2048 x 1536 pixels · fundus photo: 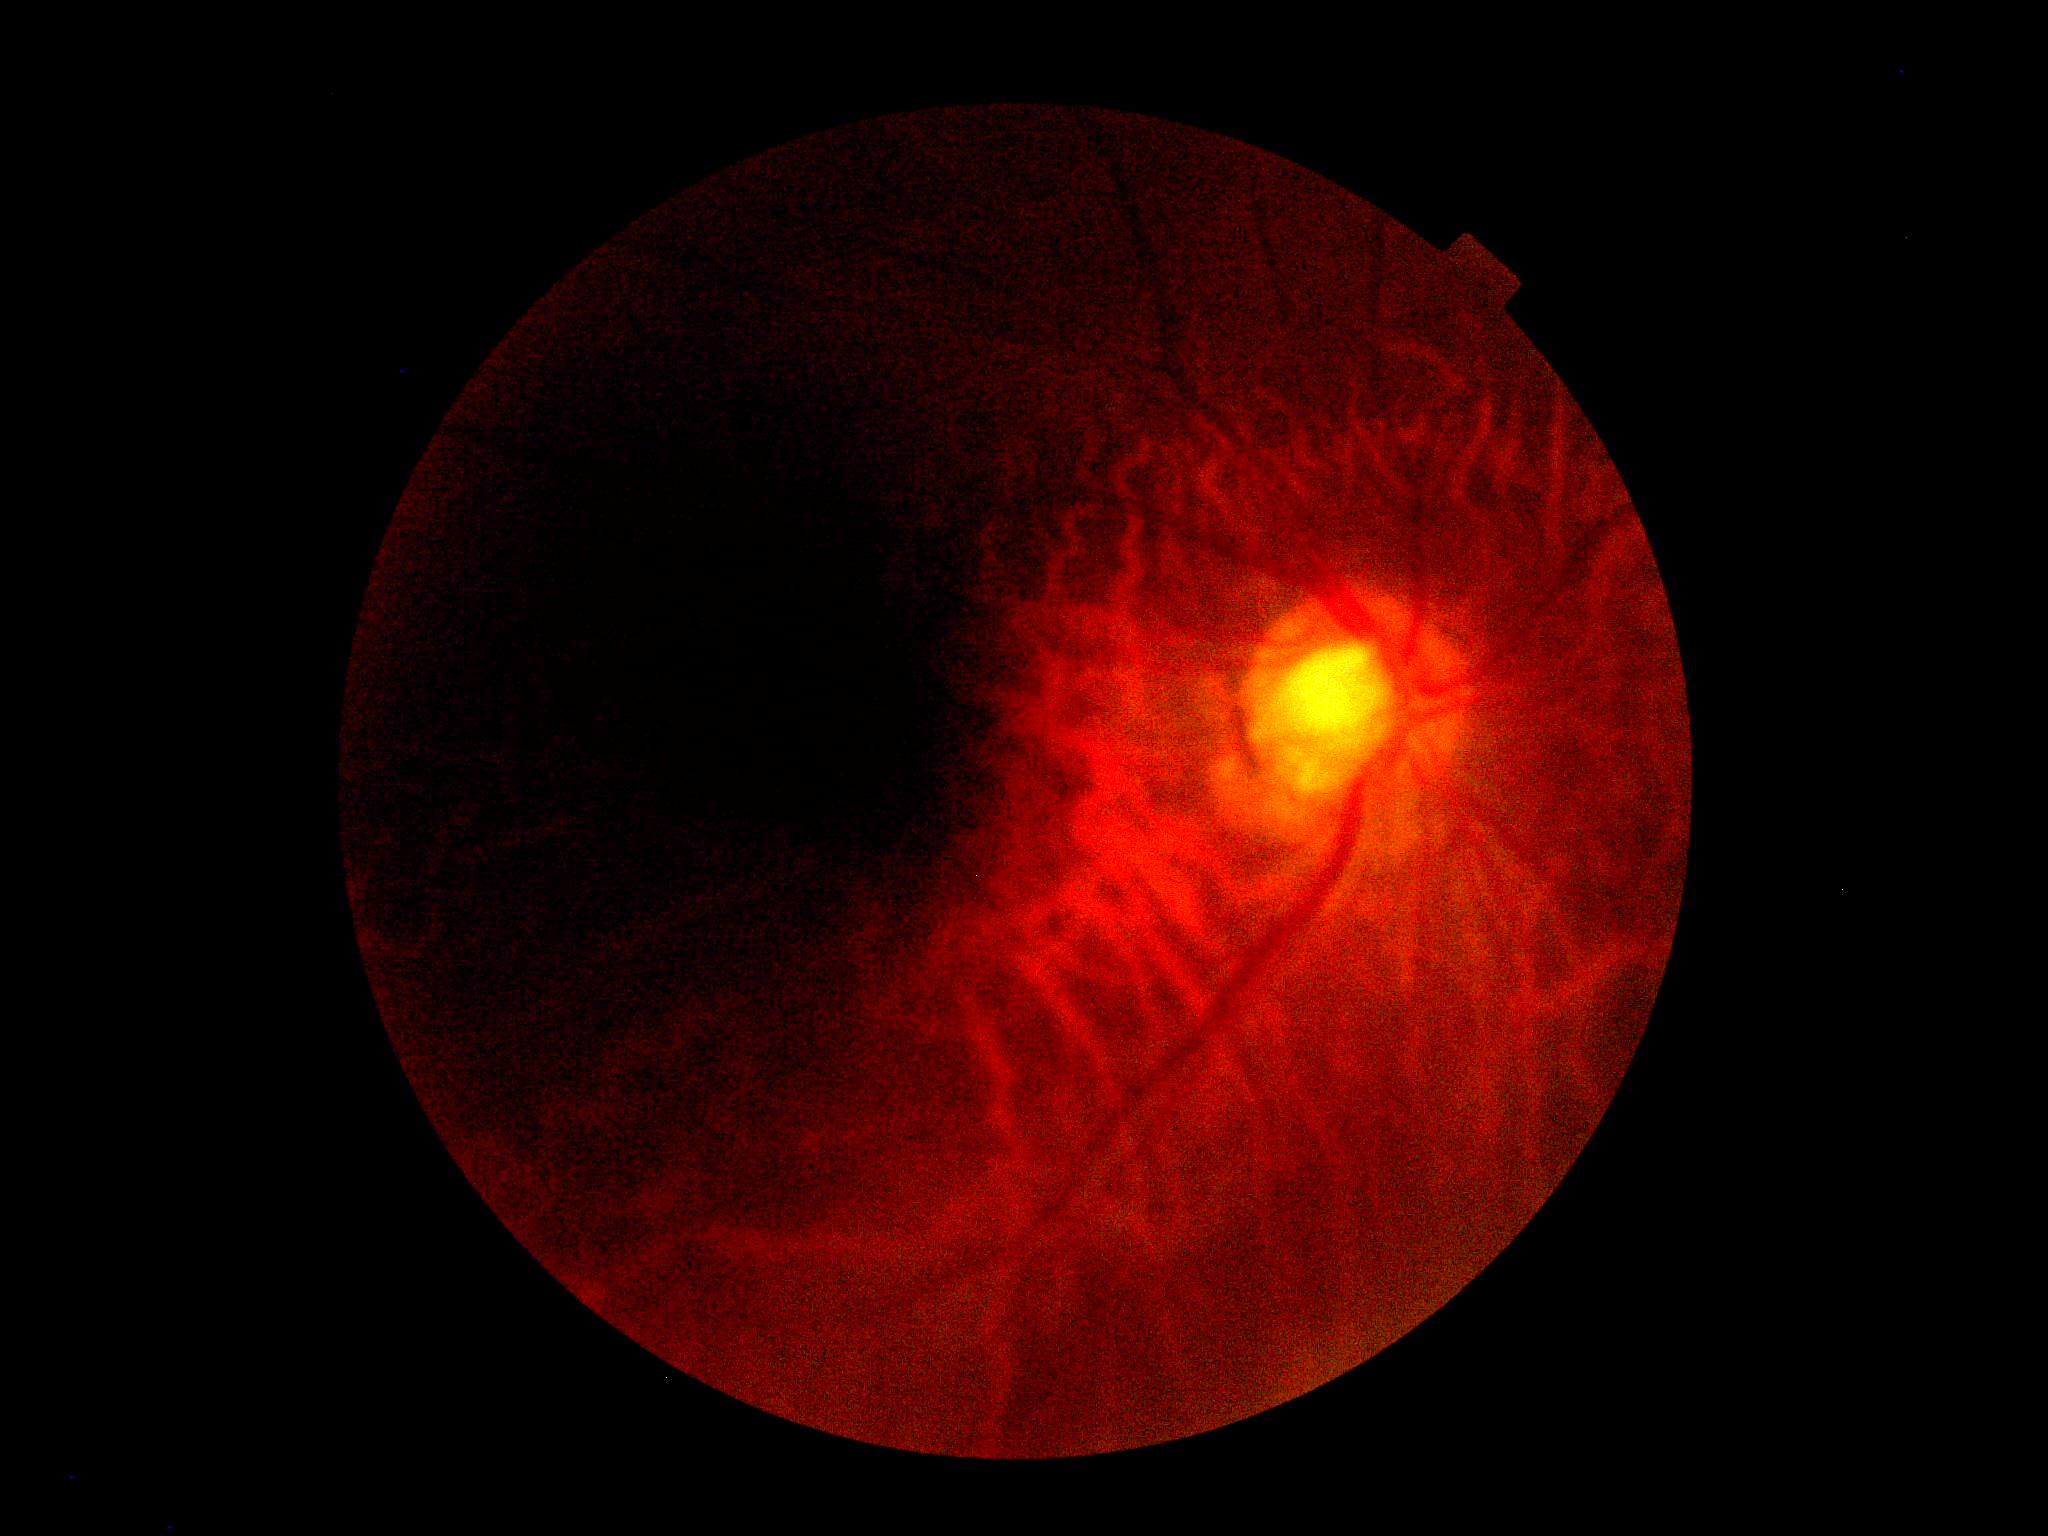 Diabetic retinopathy (DR) is ungradable due to poor image quality. Image quality is insufficient for diabetic retinopathy assessment.